45-degree field of view — 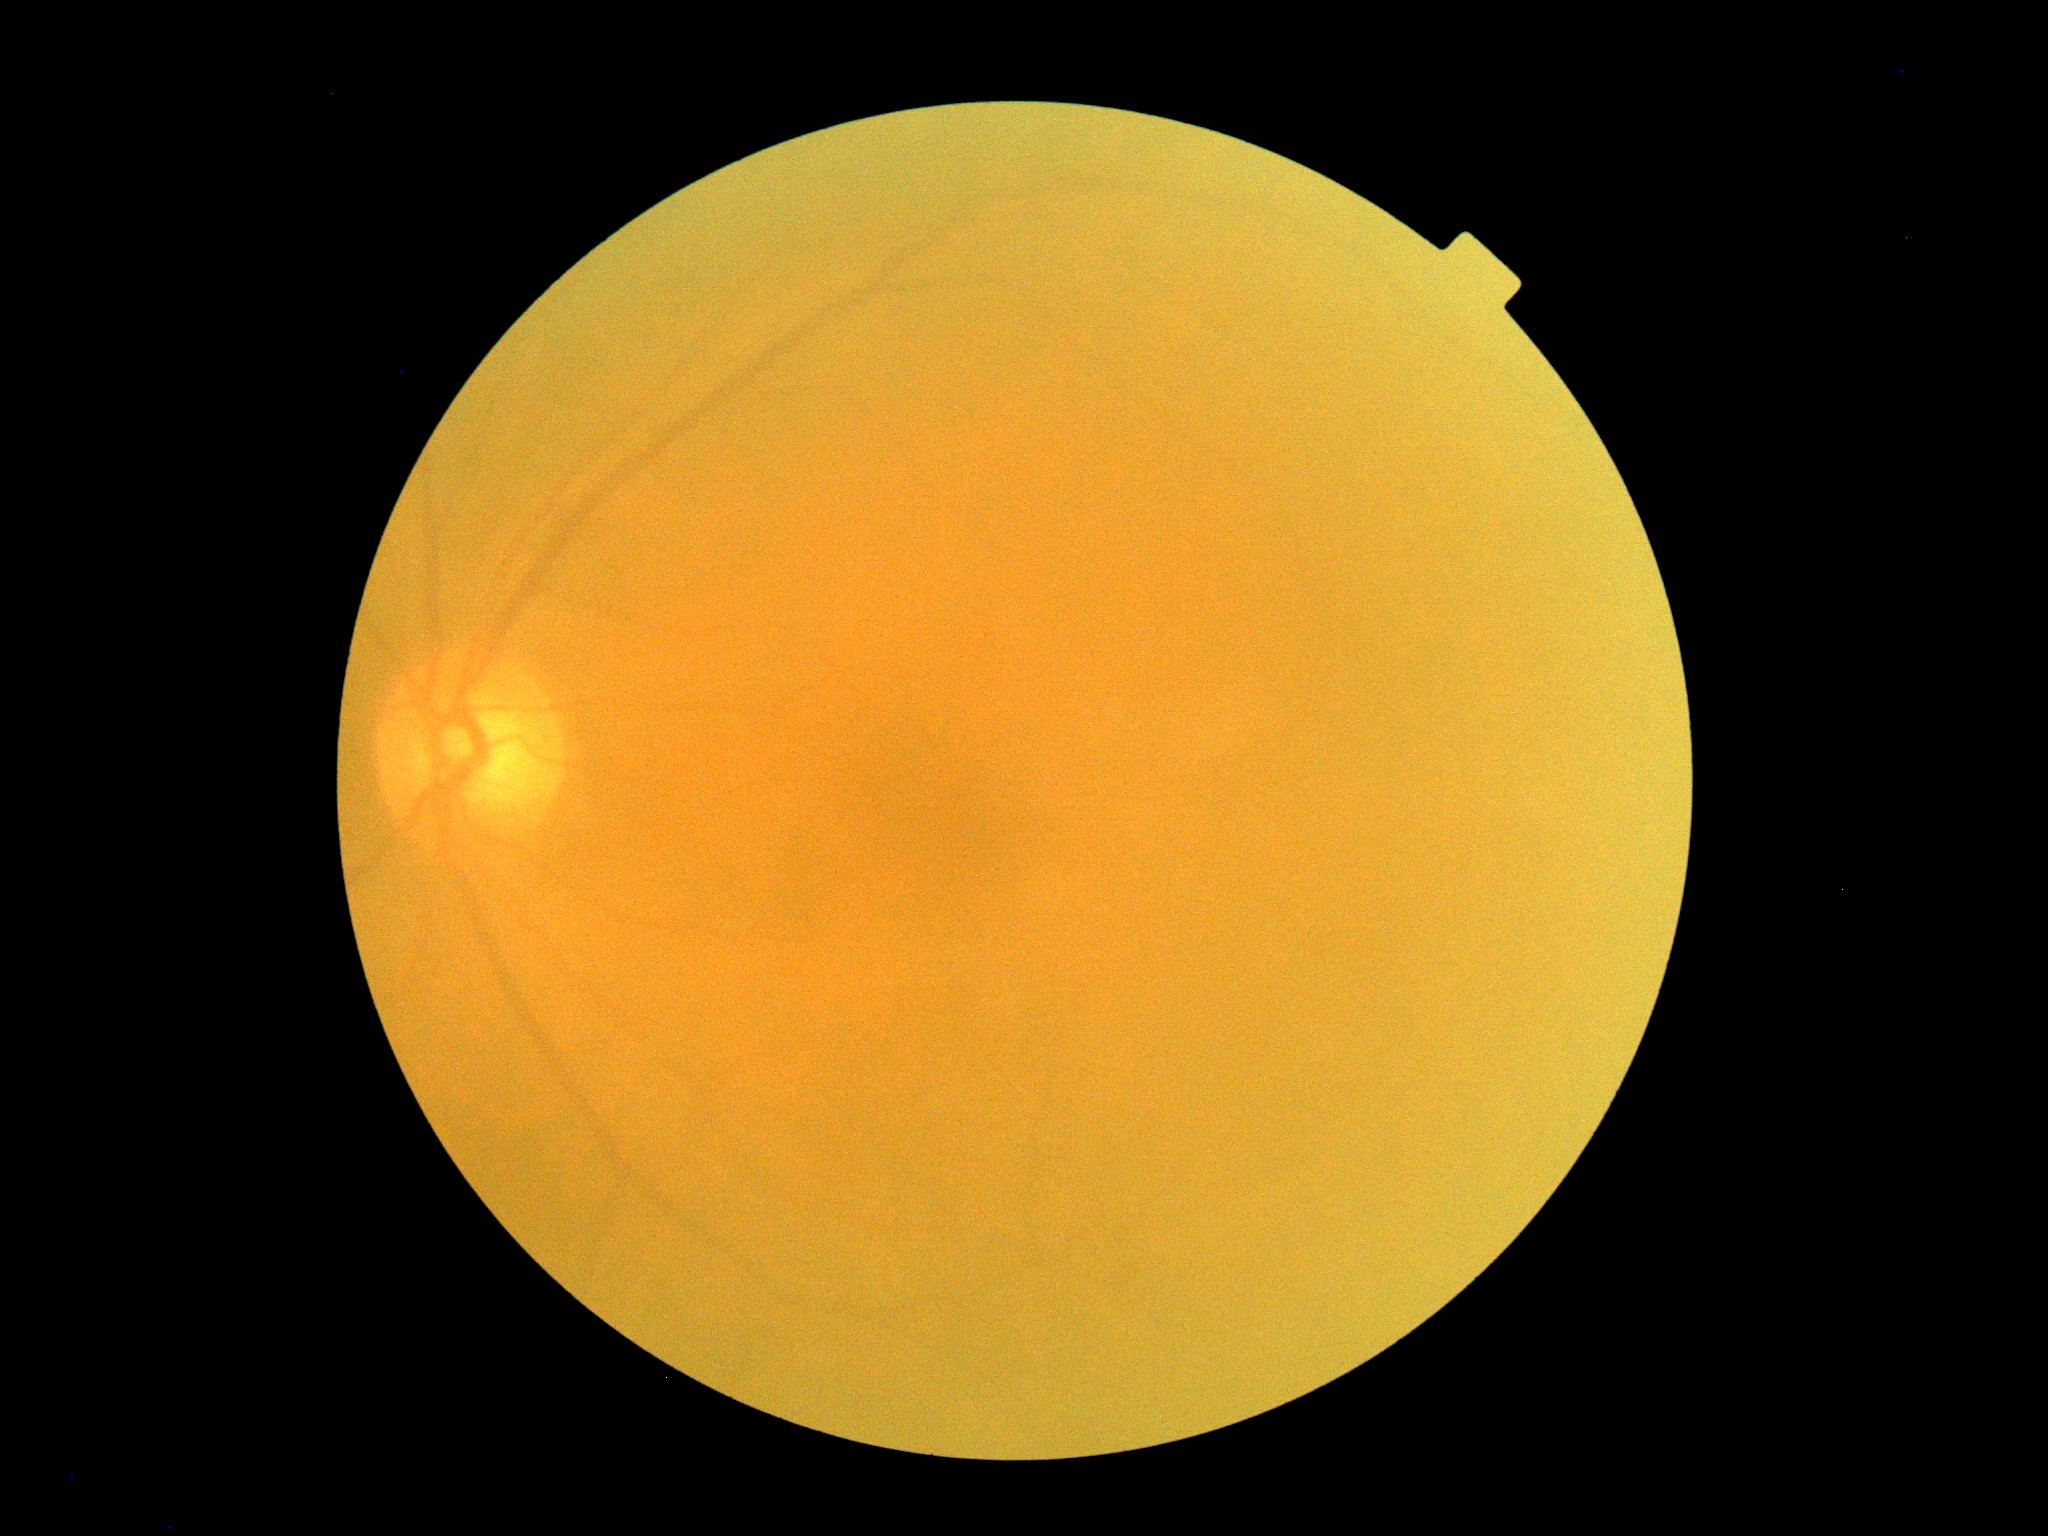 DR: grade 0 (no apparent retinopathy). No signs of diabetic retinopathy.